848x848; 45° FOV — 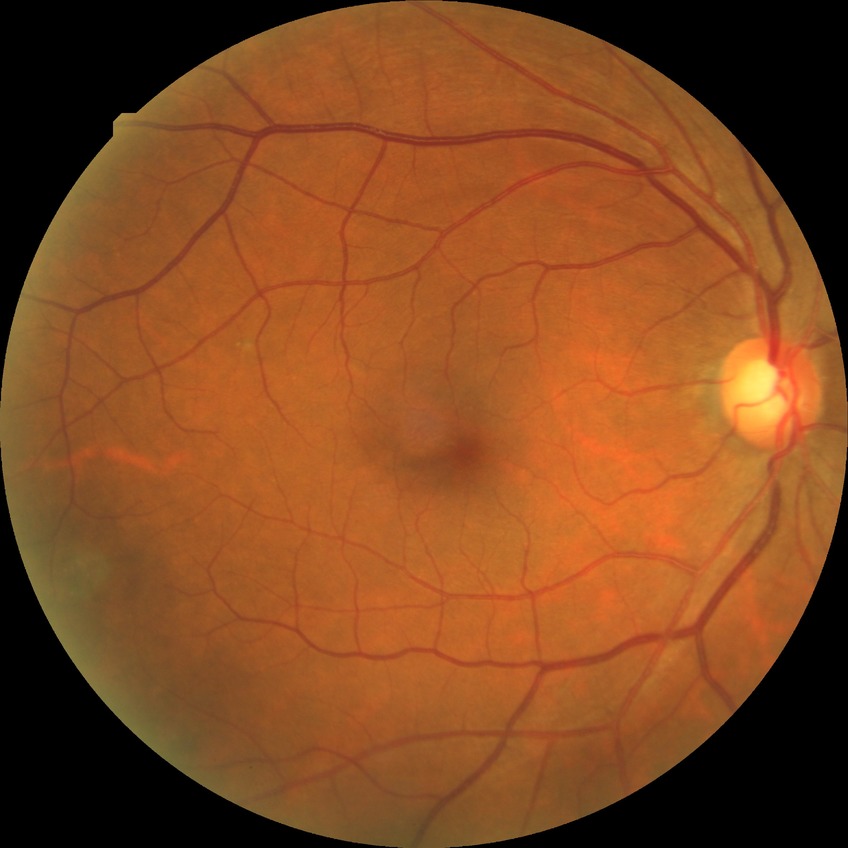

Findings:
• diabetic retinopathy (DR) — NDR (no diabetic retinopathy)